45-degree field of view · nonmydriatic fundus photograph
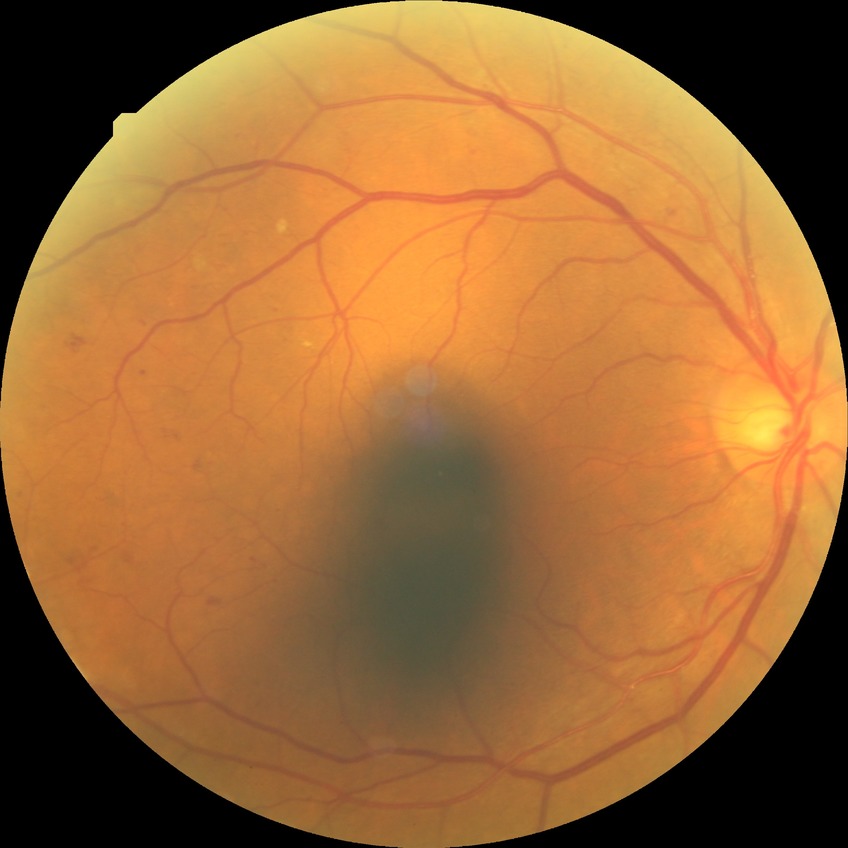
Retinopathy stage: proliferative diabetic retinopathy.